45-degree field of view, 2352 by 1568 pixels, CFP
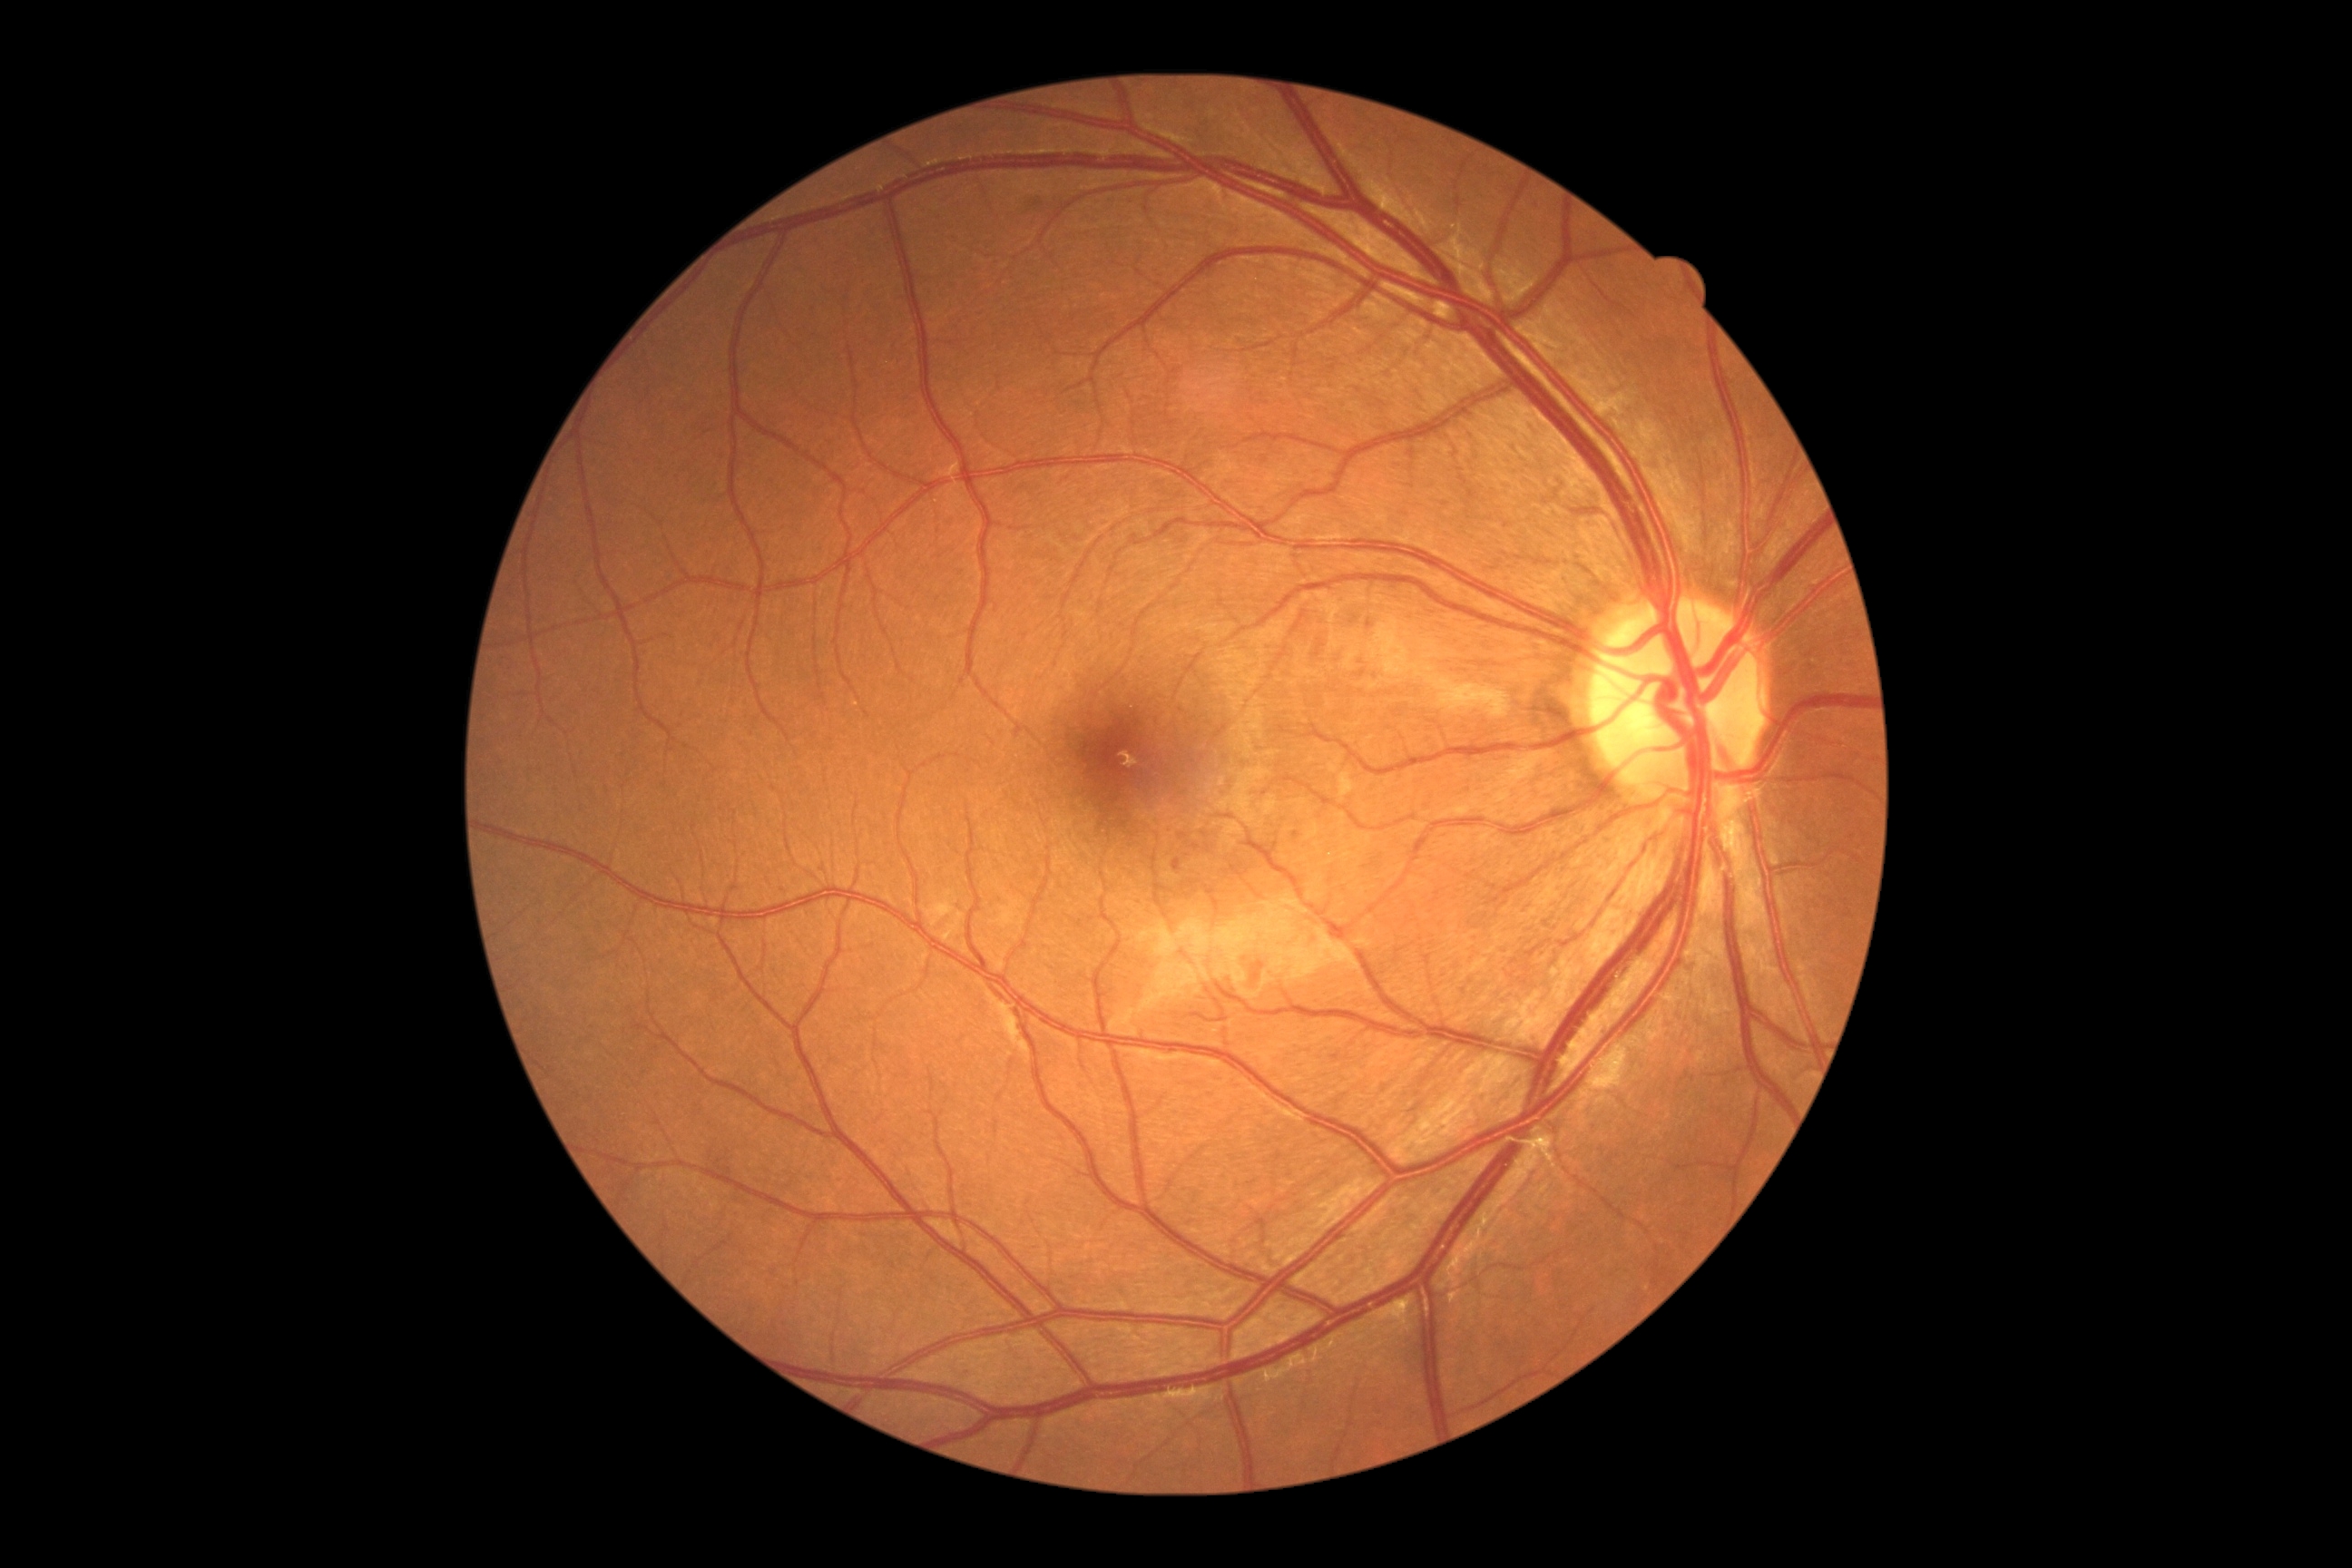

diabetic retinopathy (DR) = mild NPDR (grade 1) — presence of microaneurysms only.